Color fundus photograph centered on the optic disc, Topcon TRC fundus camera, FOV 35° before cropping
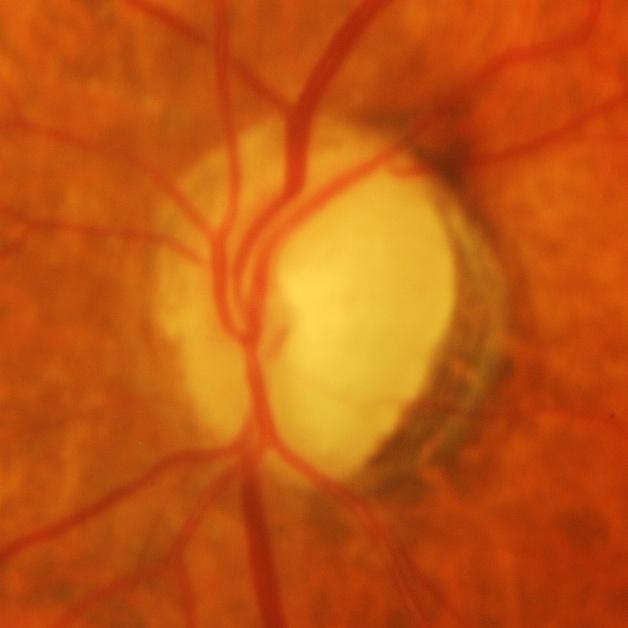
Q: Is glaucoma present?
A: Glaucomatous findings.